Fundus photo. 45° FOV. 2352x1568px.
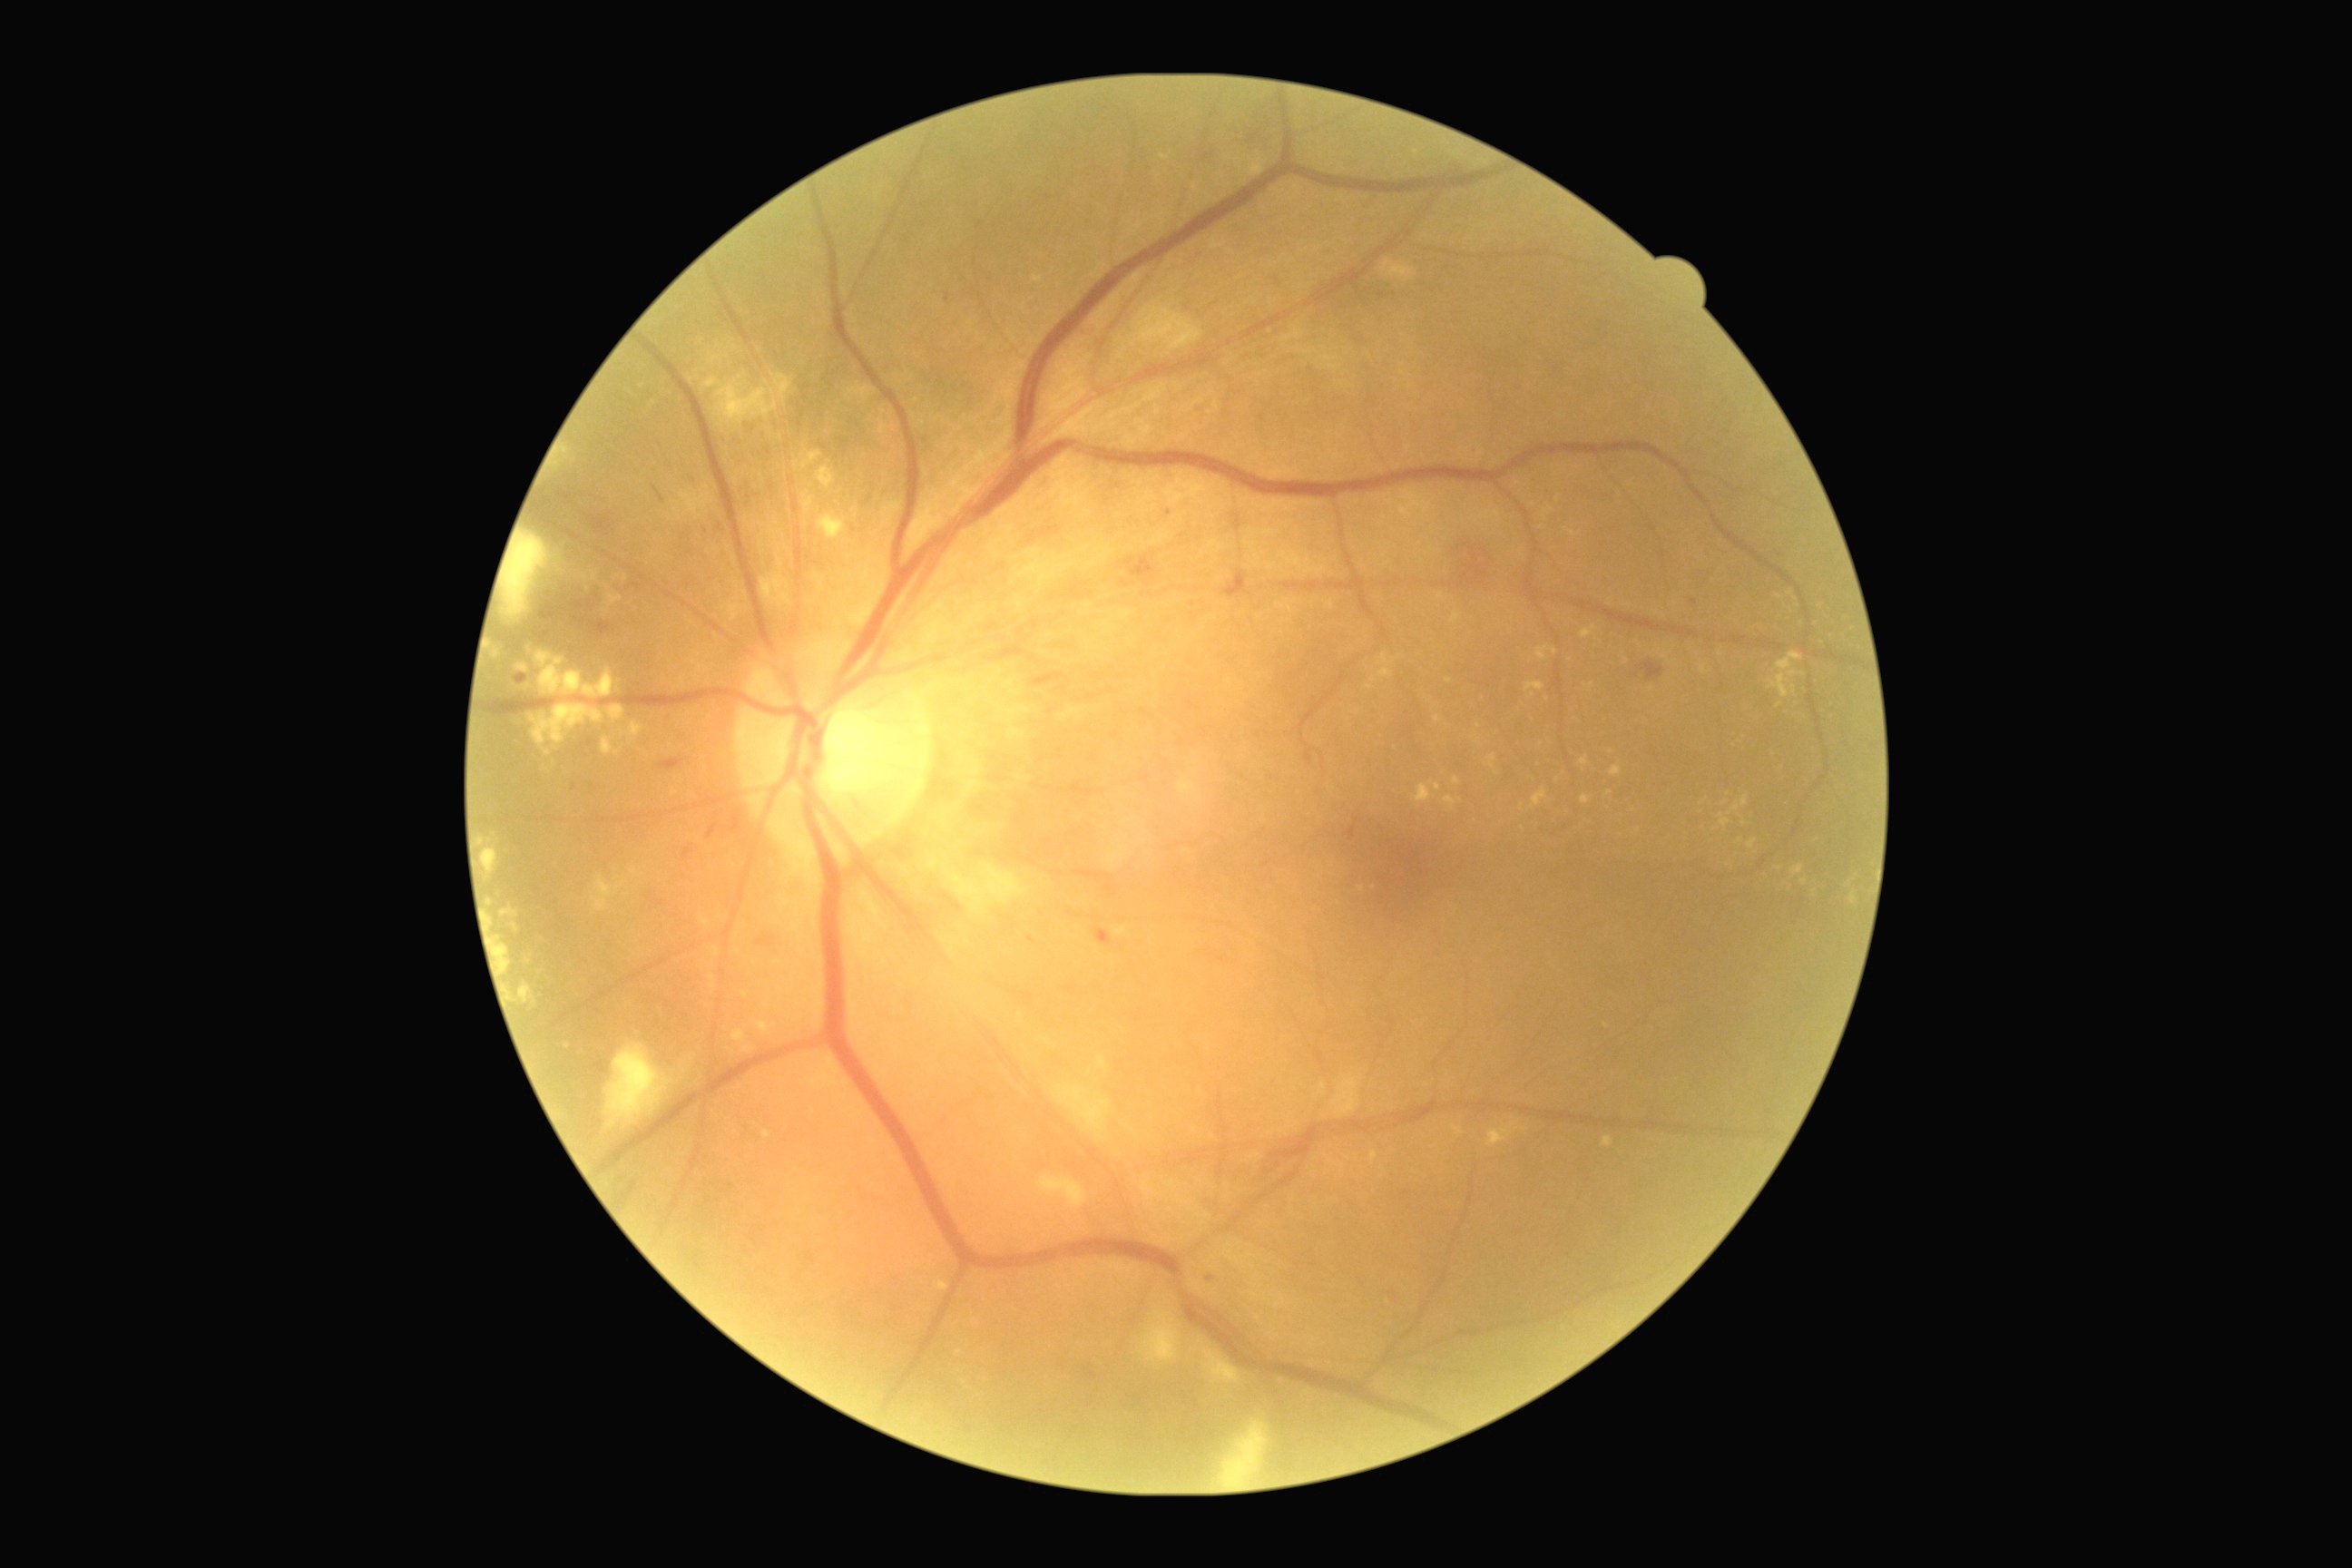

DR severity is moderate non-proliferative diabetic retinopathy (grade 2).